Wide-field fundus photograph from neonatal ROP screening. Acquired on the Natus RetCam Envision.
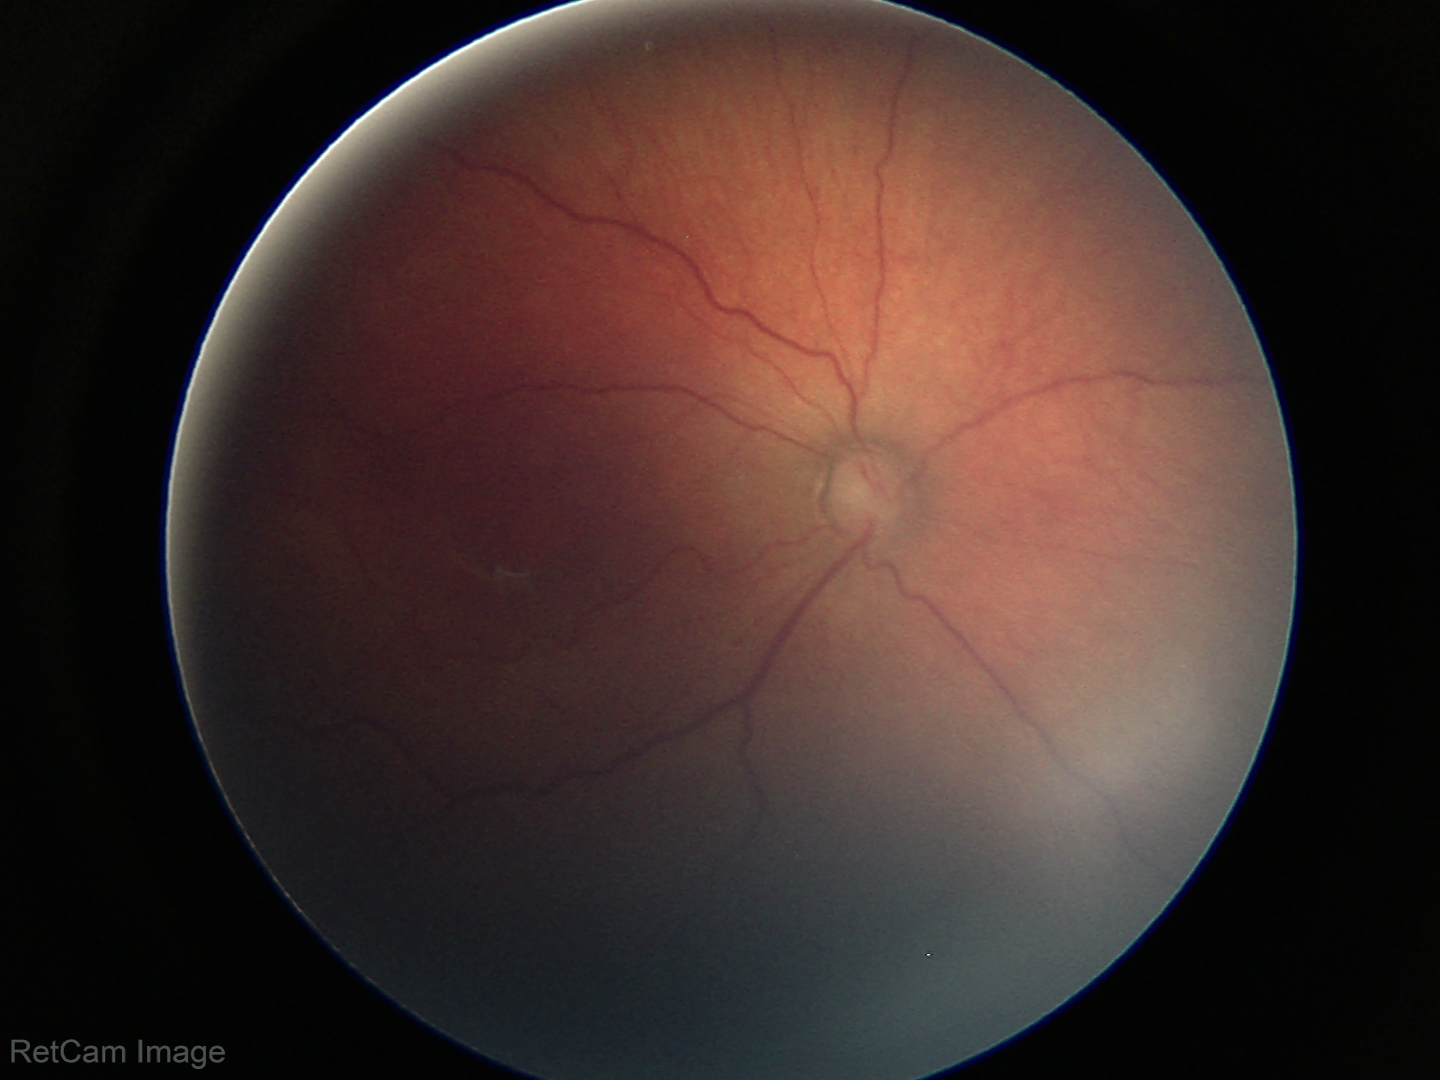

Series diagnosed as retinopathy of prematurity (ROP) stage 3. No plus disease.